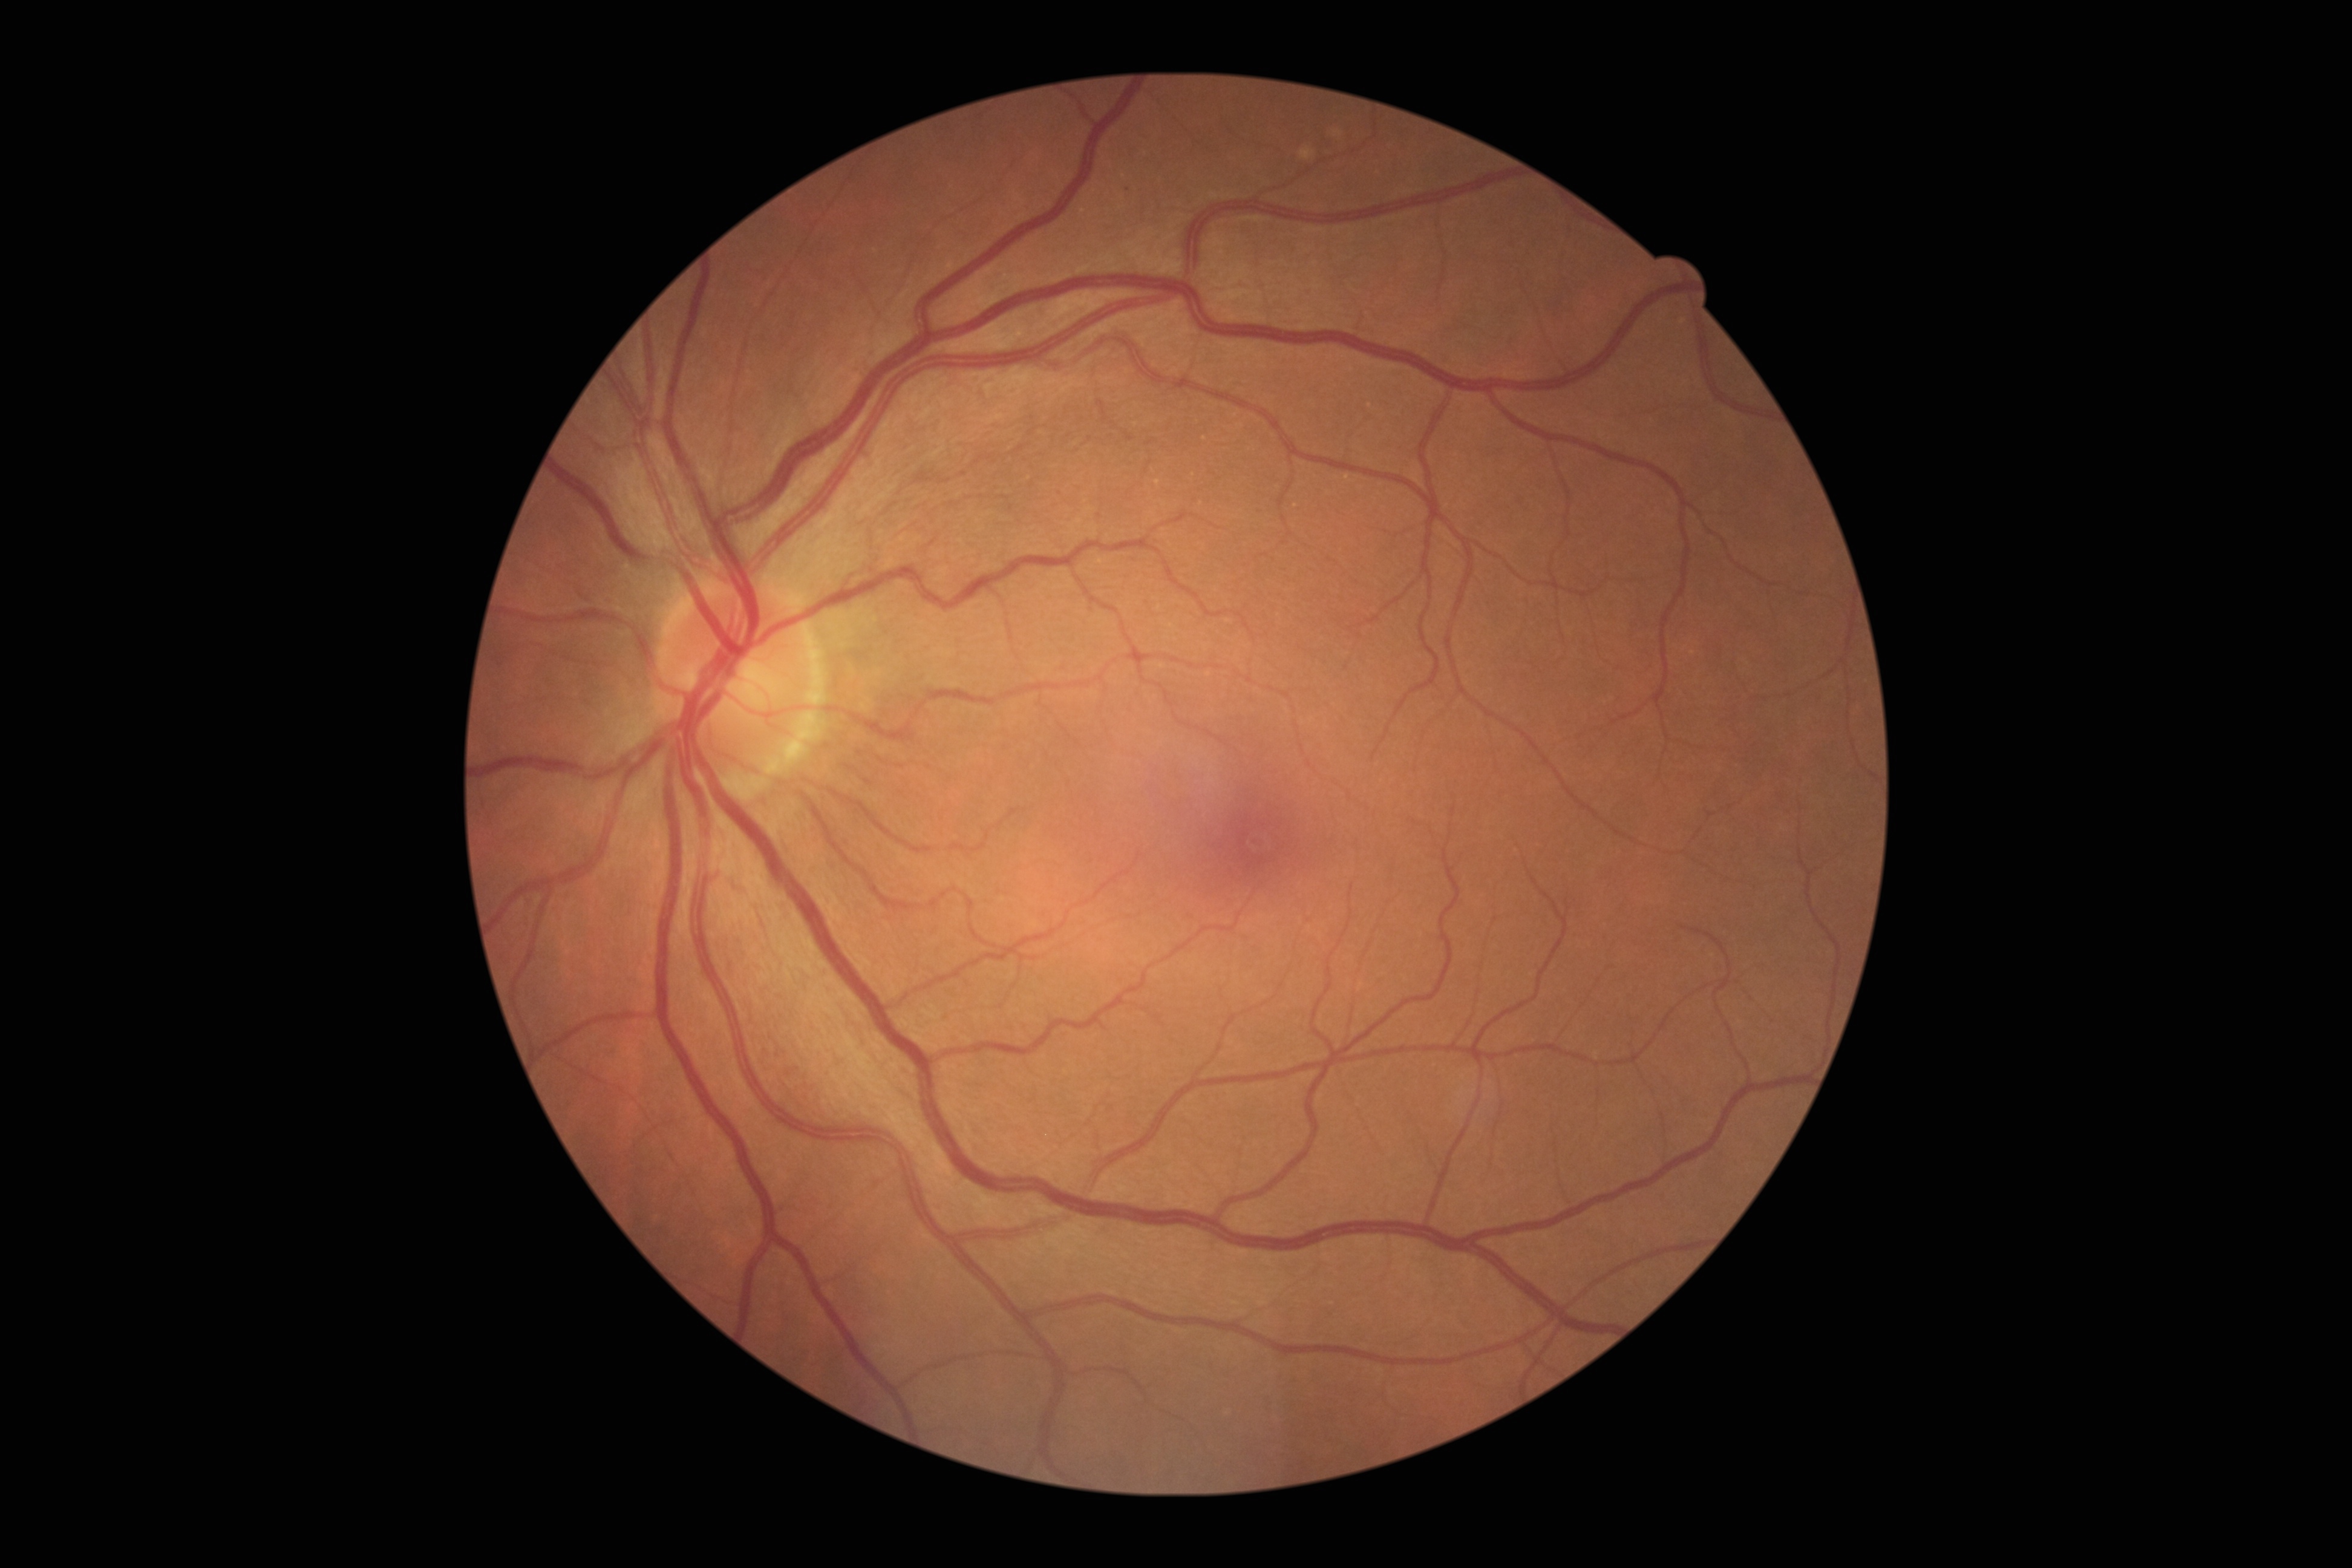
DR impression: no DR findings; diabetic retinopathy: grade 0.